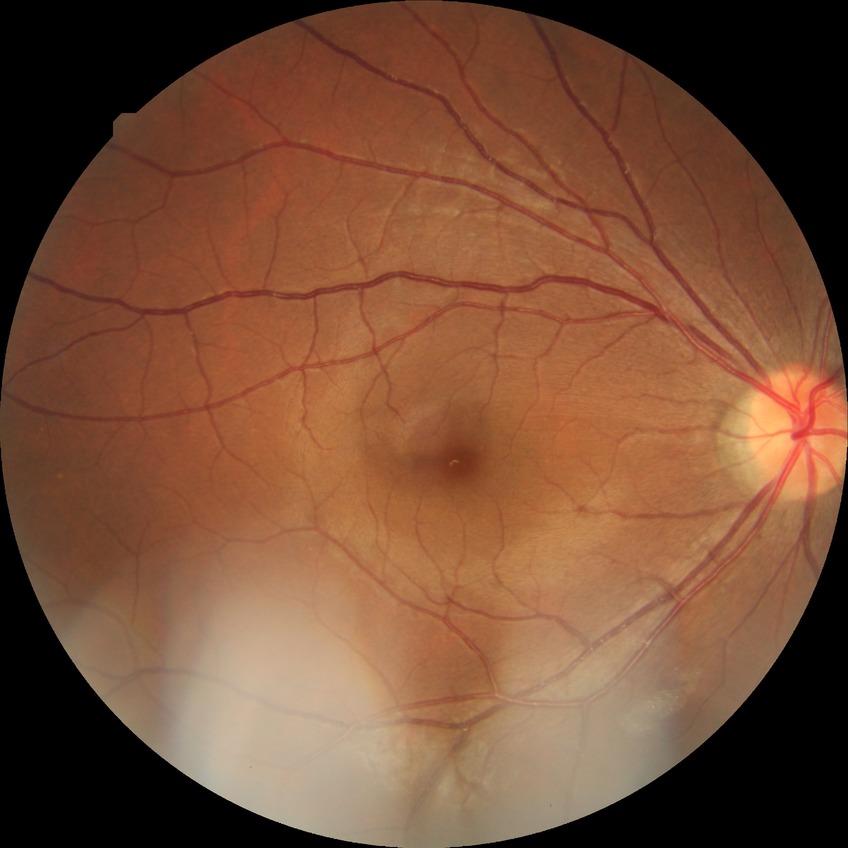
diabetic retinopathy (DR)@no diabetic retinopathy (NDR).